Wide-field fundus photograph of an infant · camera: Clarity RetCam 3 (130° FOV) · 640x480.
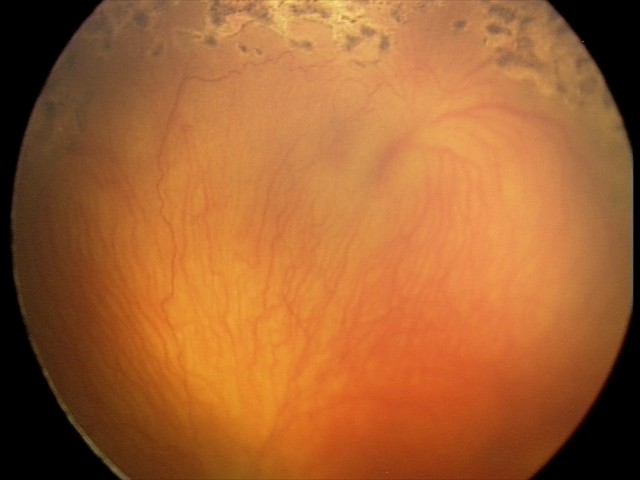
Plus form: present | impression: aggressive retinopathy of prematurity — rapidly progressive severe ROP with prominent plus disease, often without classic stage progression.